45-degree field of view; retinal fundus photograph; 2352x1568
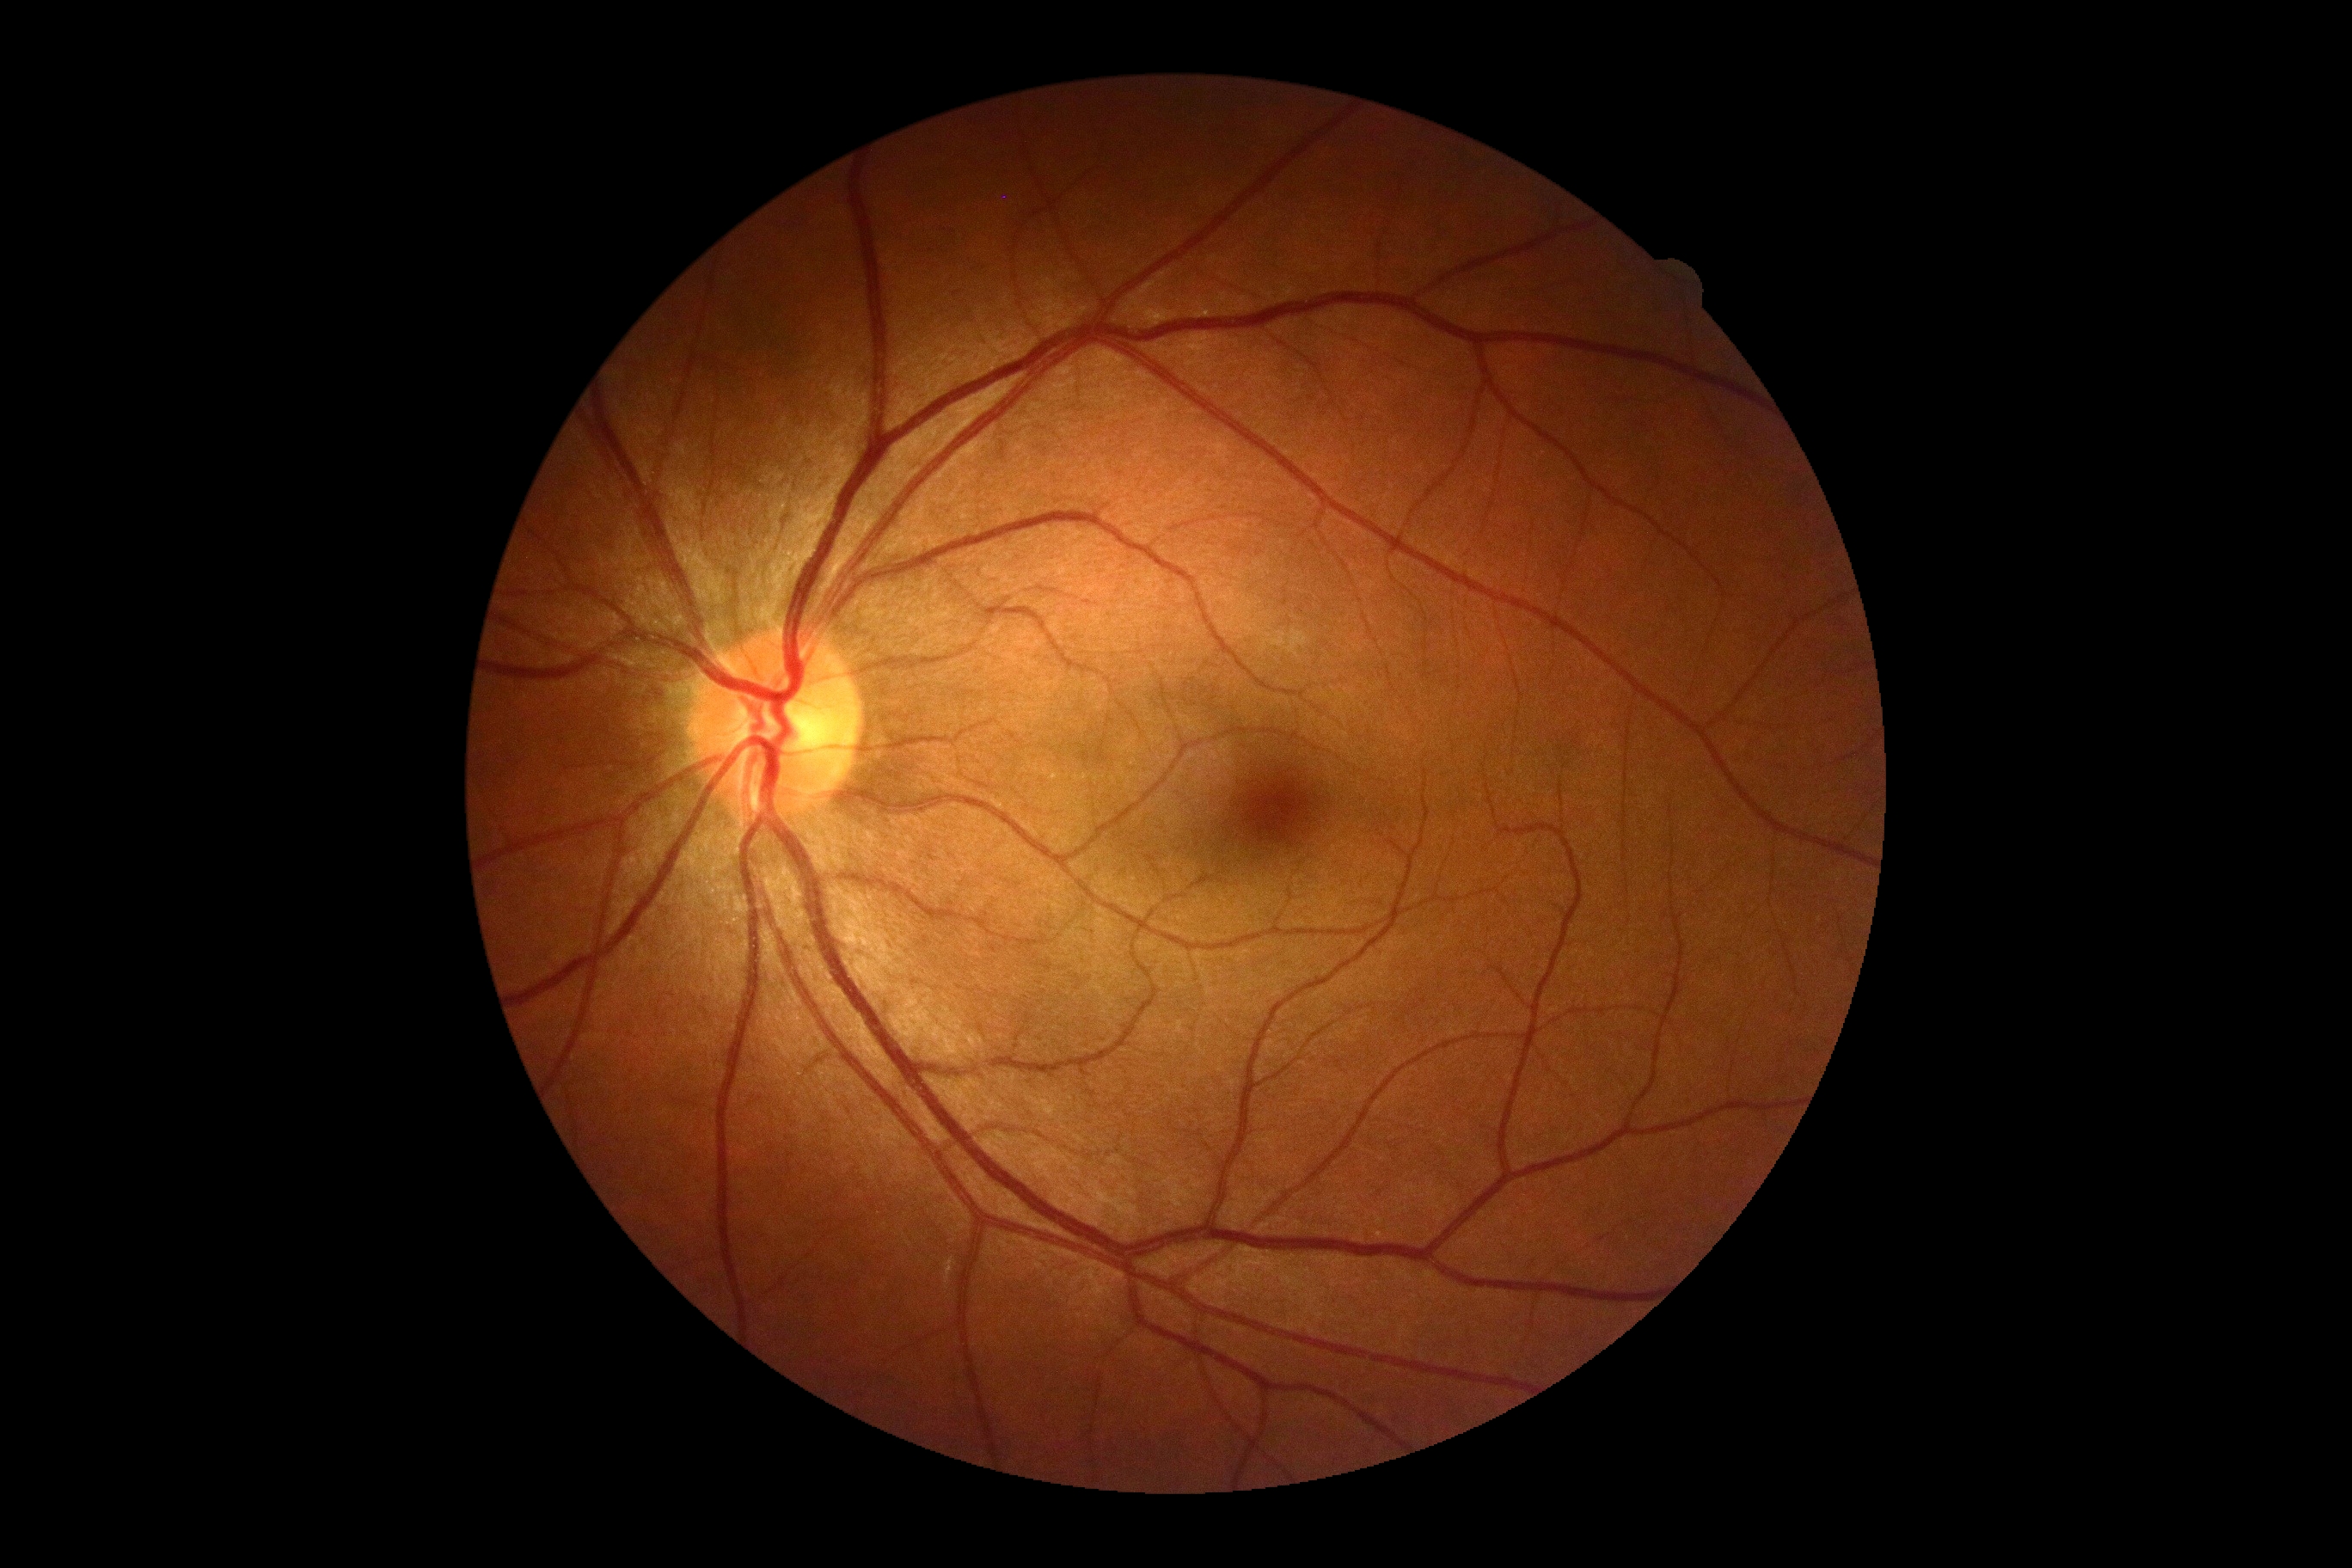

No signs of diabetic retinopathy. Retinopathy grade: 0/4.